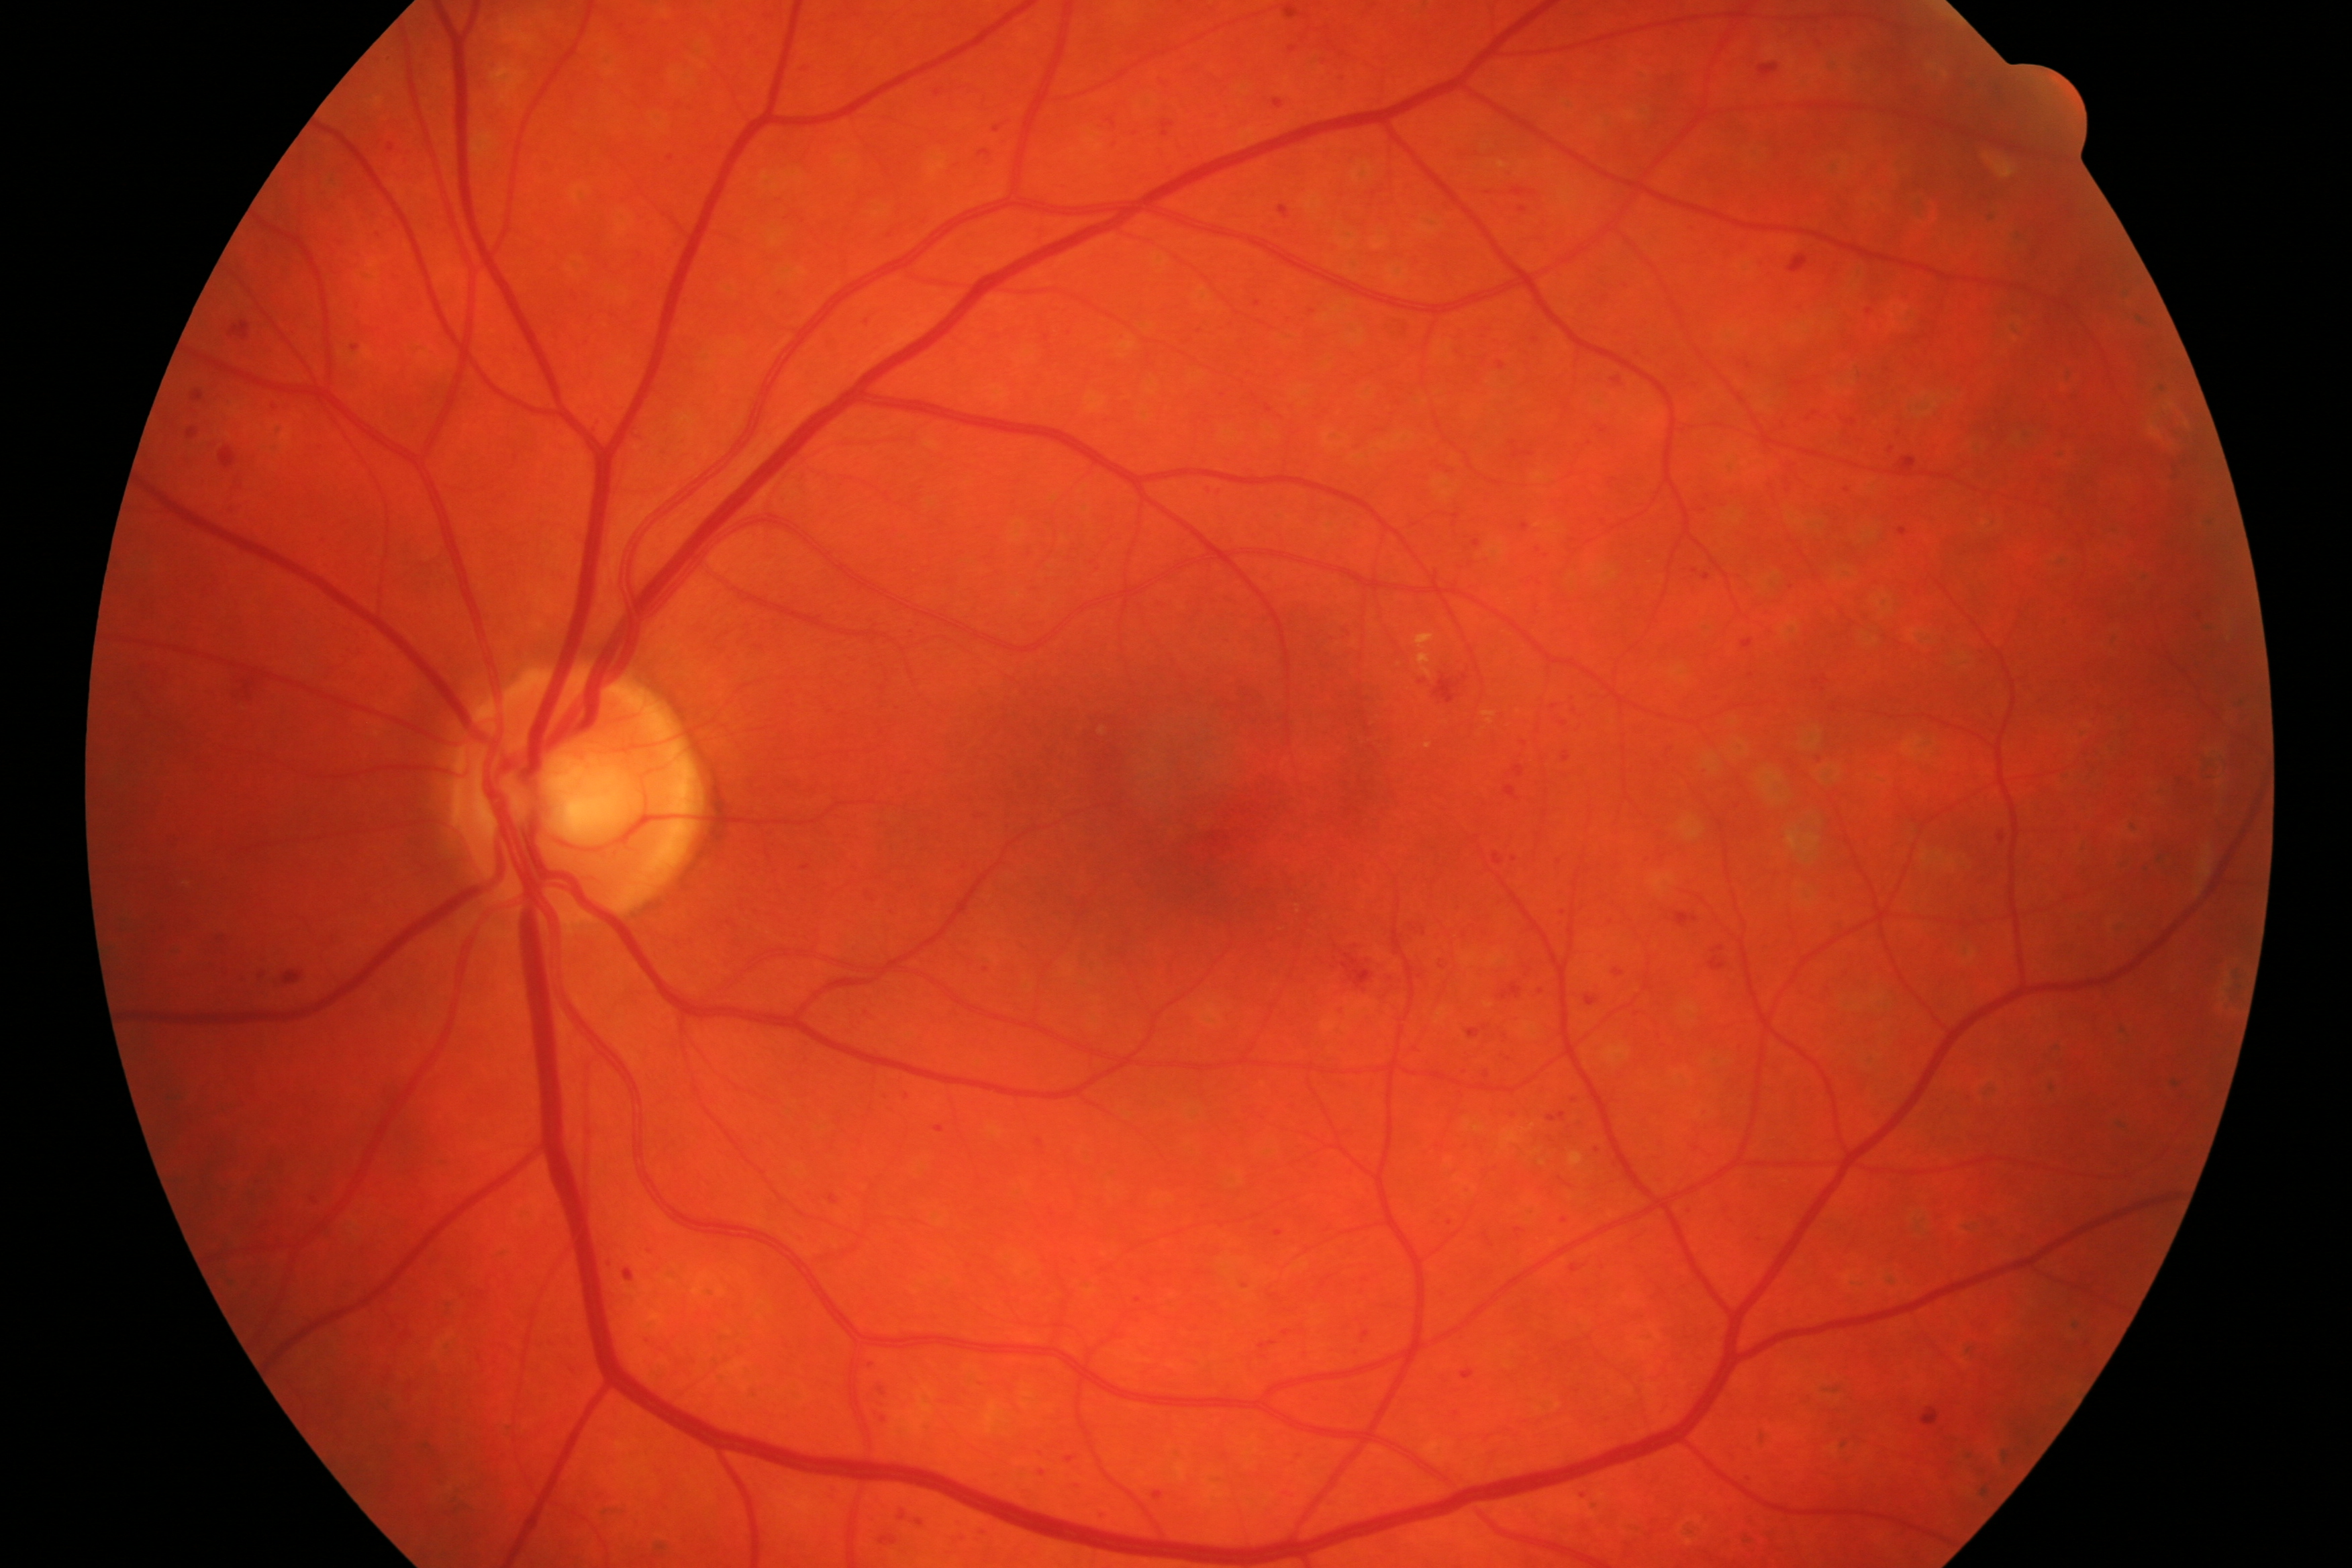

Demonstrates DR.